RetCam wide-field infant fundus image: 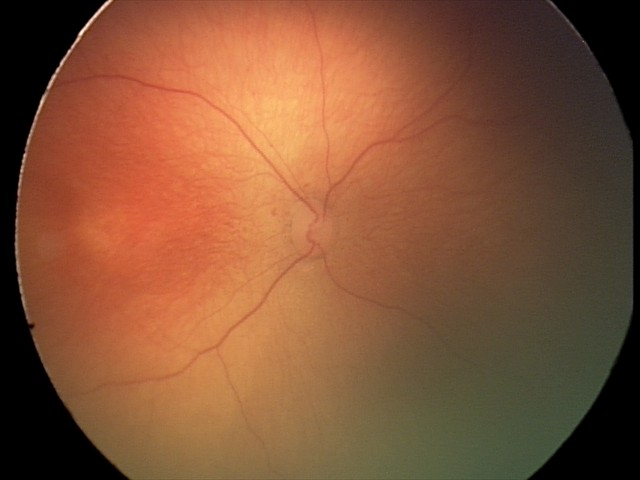 Screening series with retinopathy of prematurity stage 1. Plus disease absent.